Wide-field contact fundus photograph of an infant. Camera: Phoenix ICON (100° FOV)
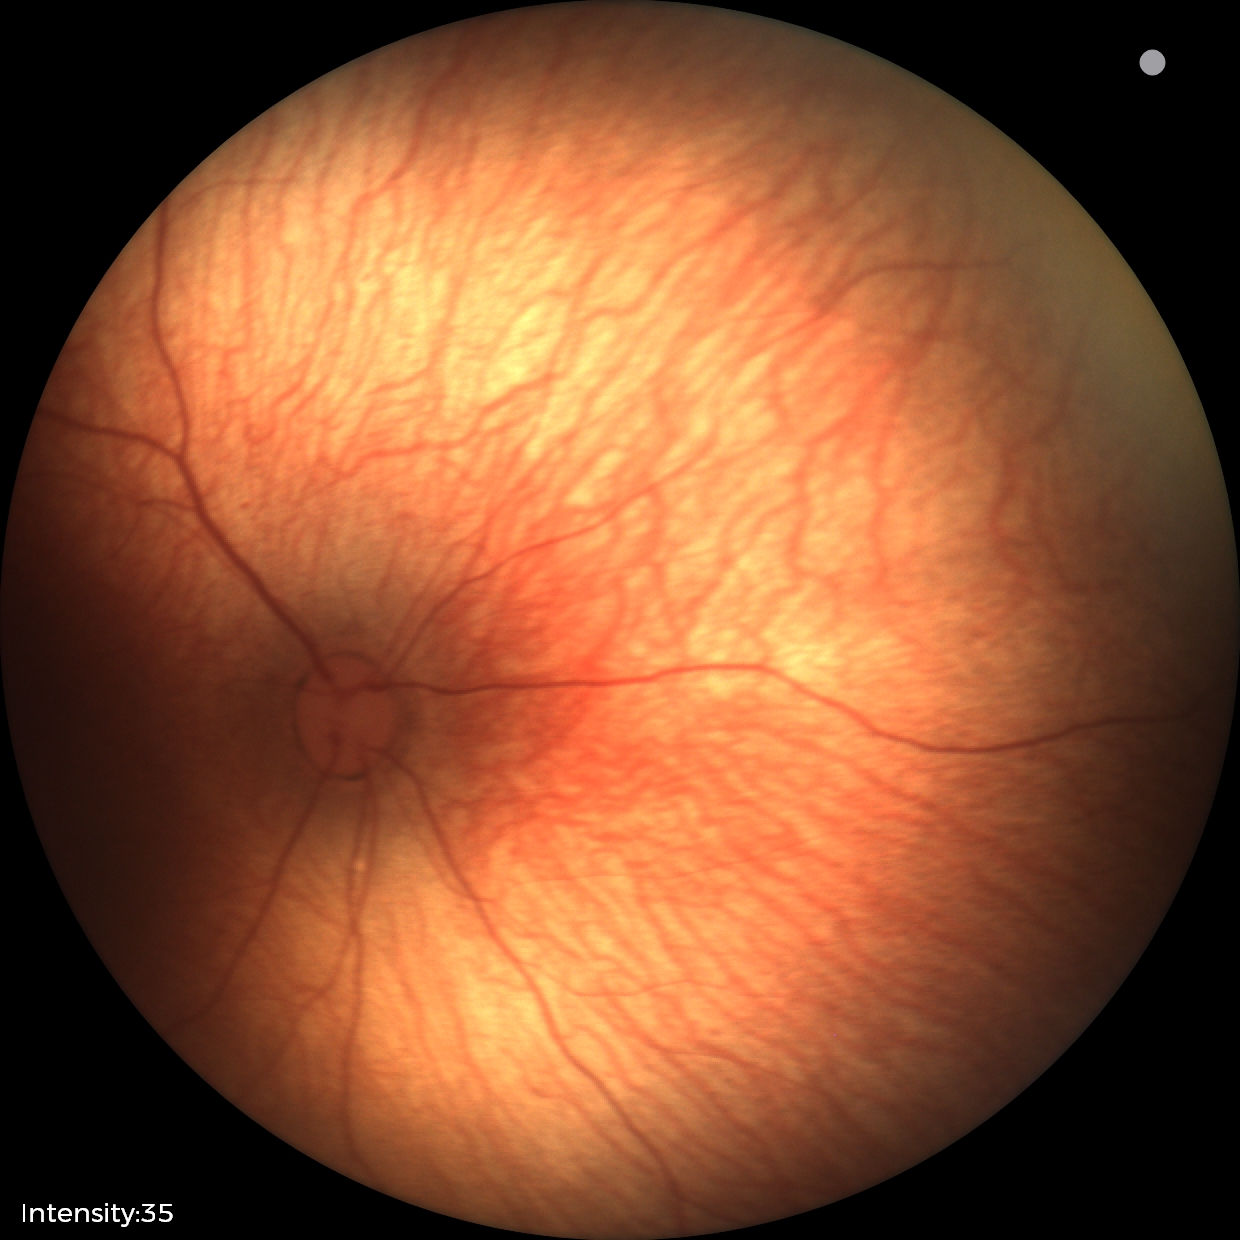 No retinal pathology identified on screening.